Image size 2048x1536:
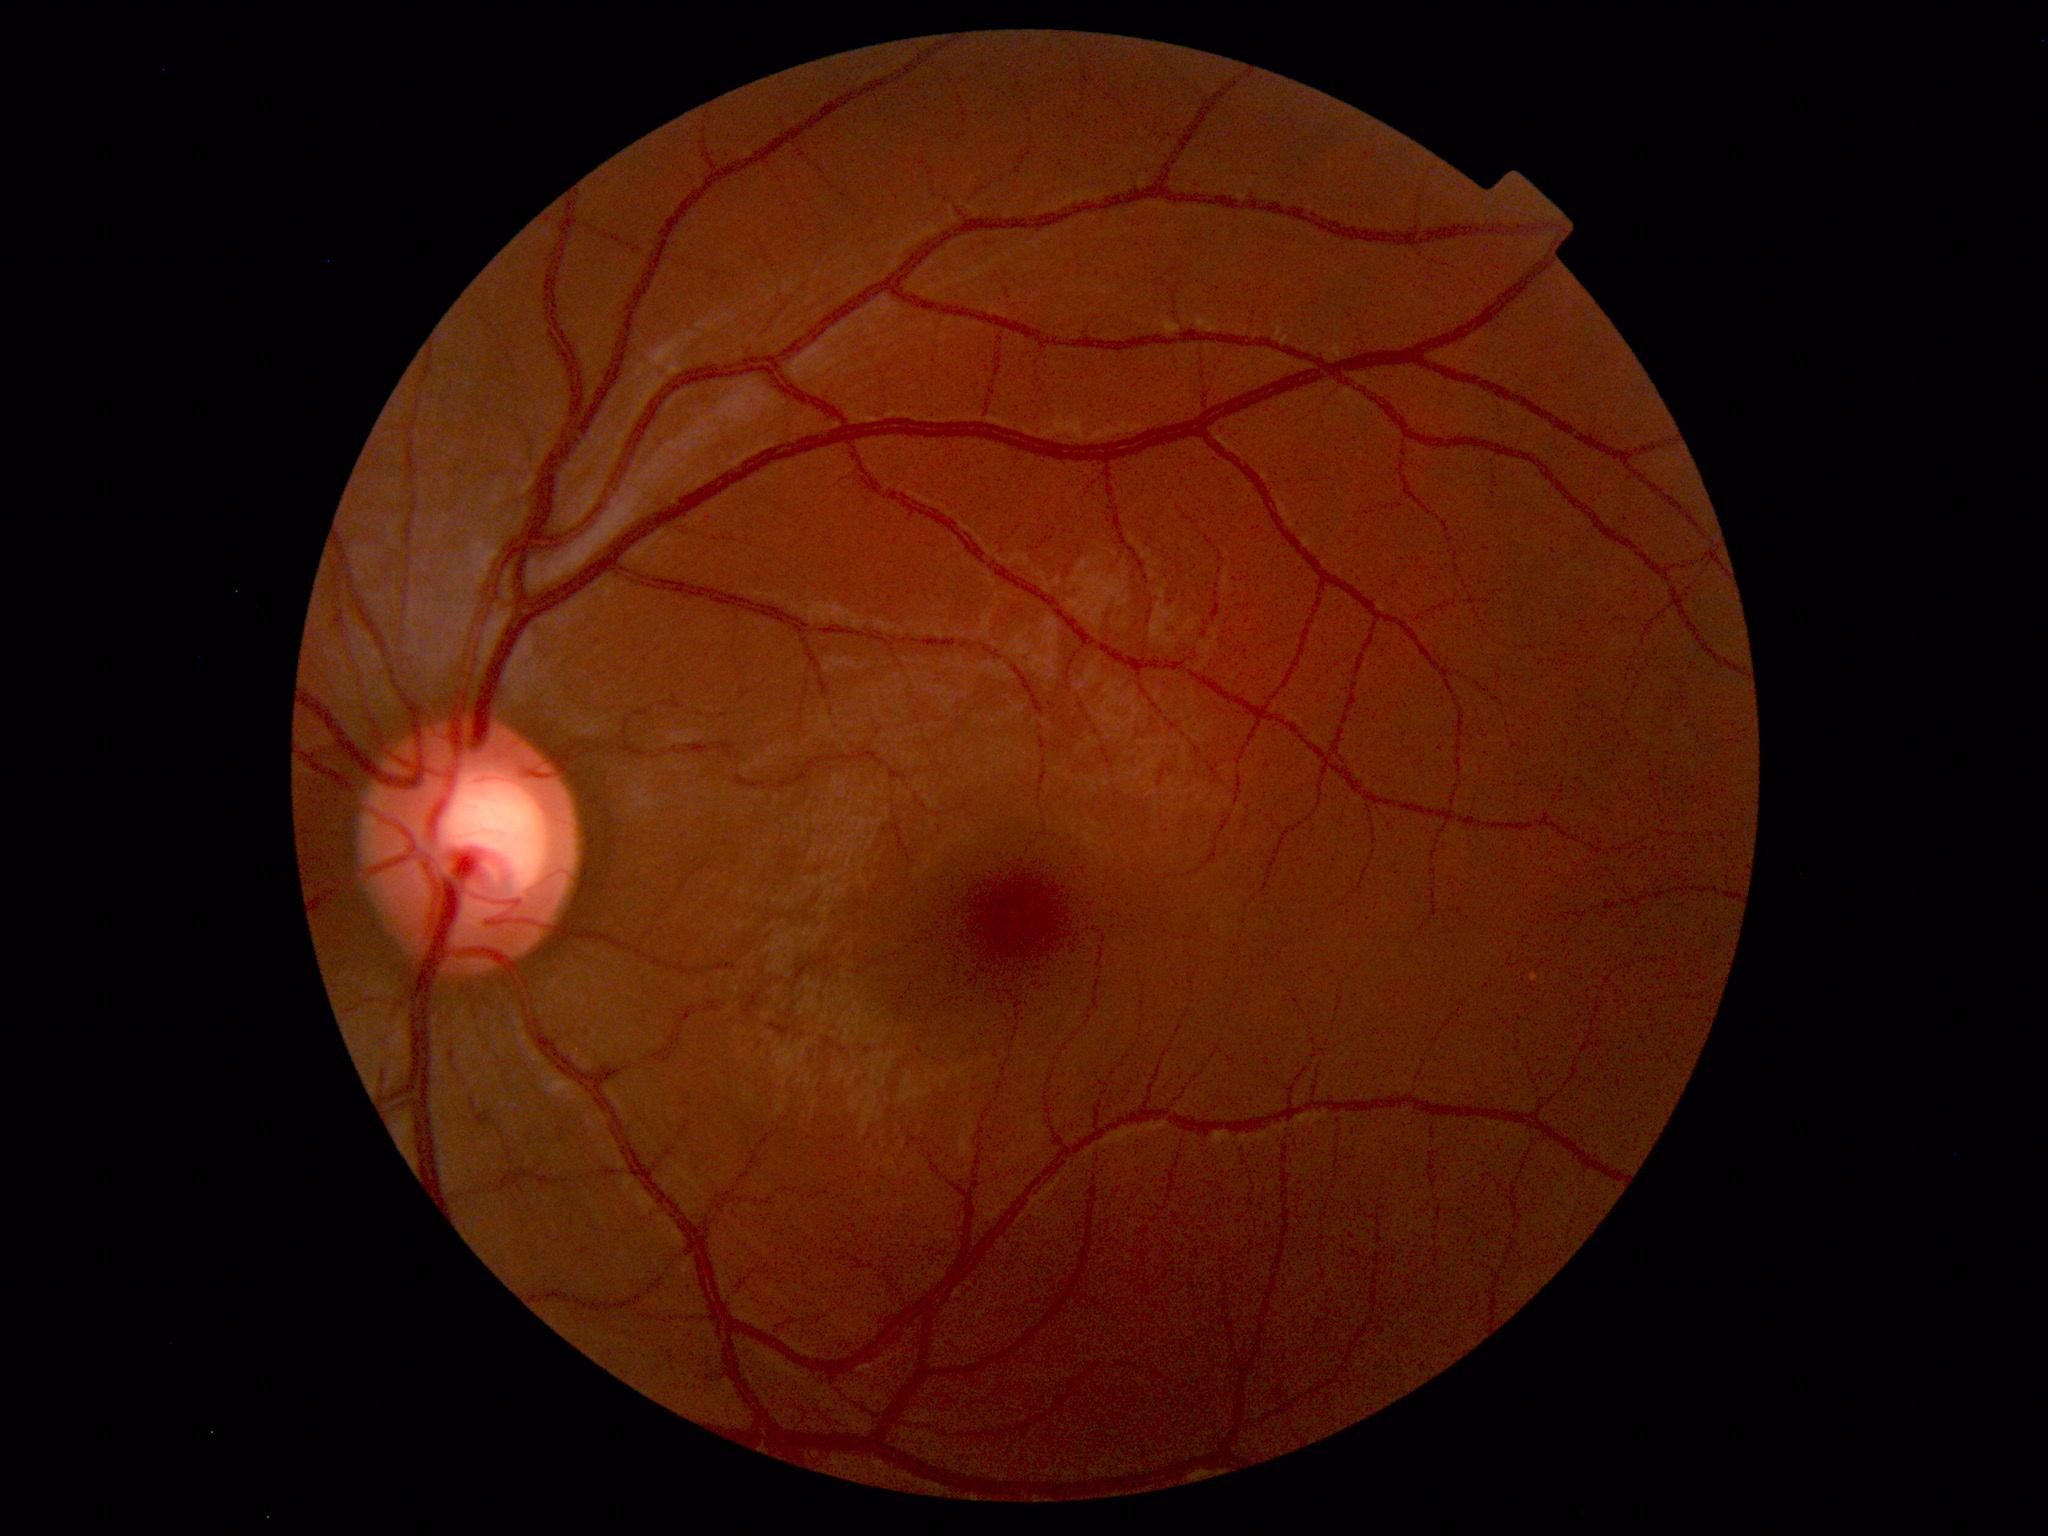

Normal retinal fundus image with no abnormalities identified.